Ultra-widefield fundus photograph, 1924 x 1556 pixels, 200° FOV: 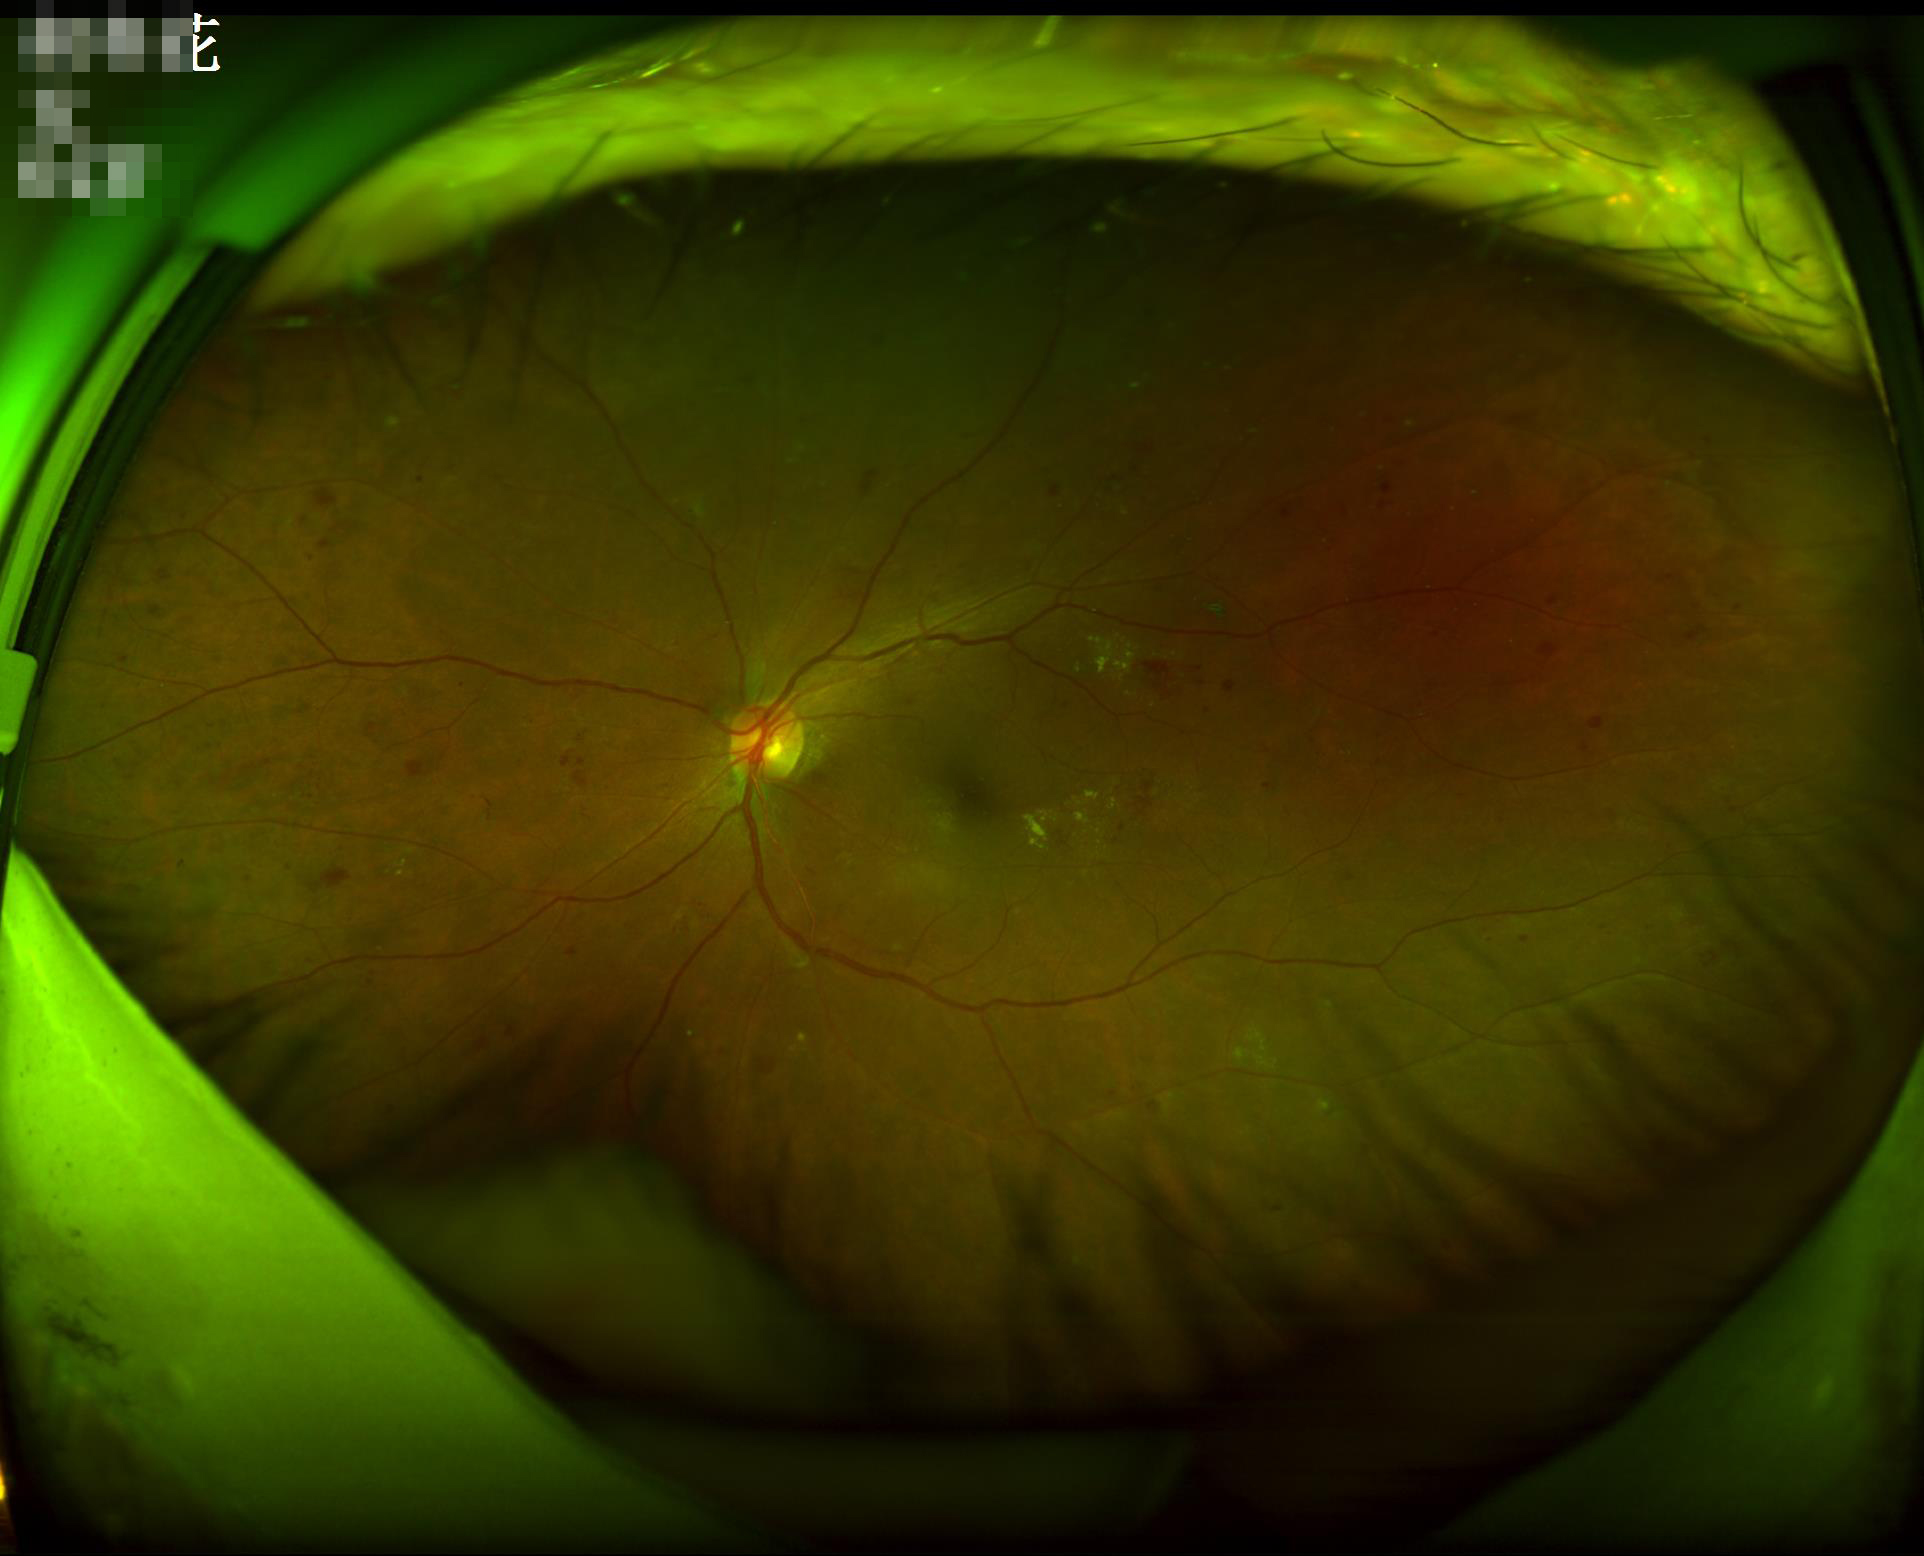 Vessels and details are readily distinguishable. Image quality is adequate for diagnostic use. Illumination is uneven. Optic disc, vessels, and background are in focus.